Diabetic retinopathy graded by the modified Davis classification, 45° field of view:
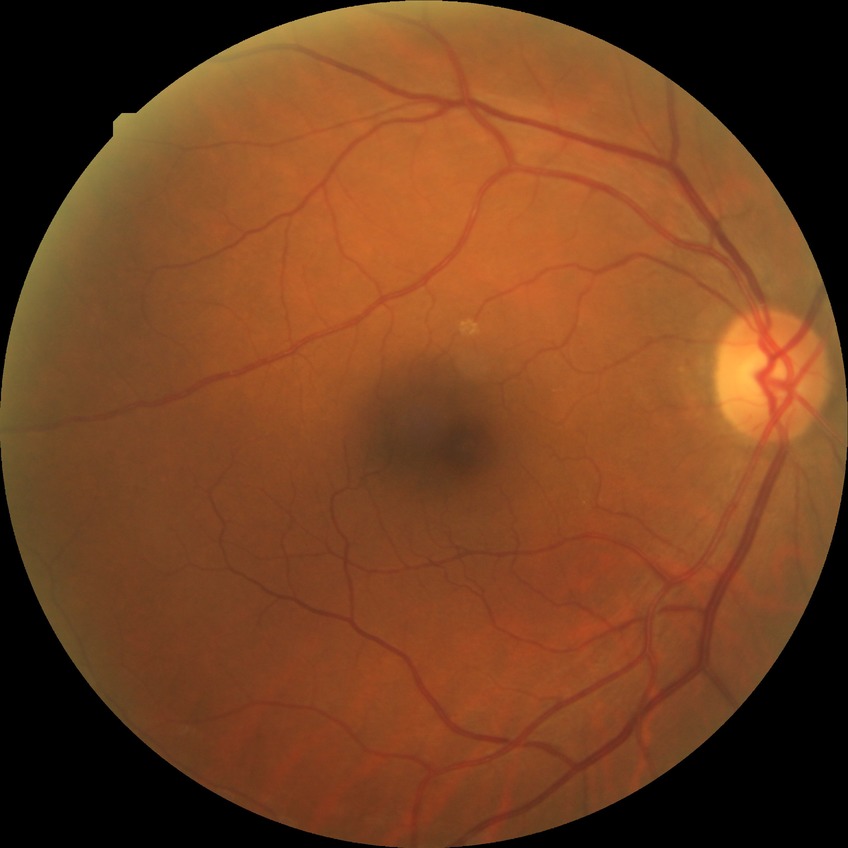
Modified Davis grading: no diabetic retinopathy.